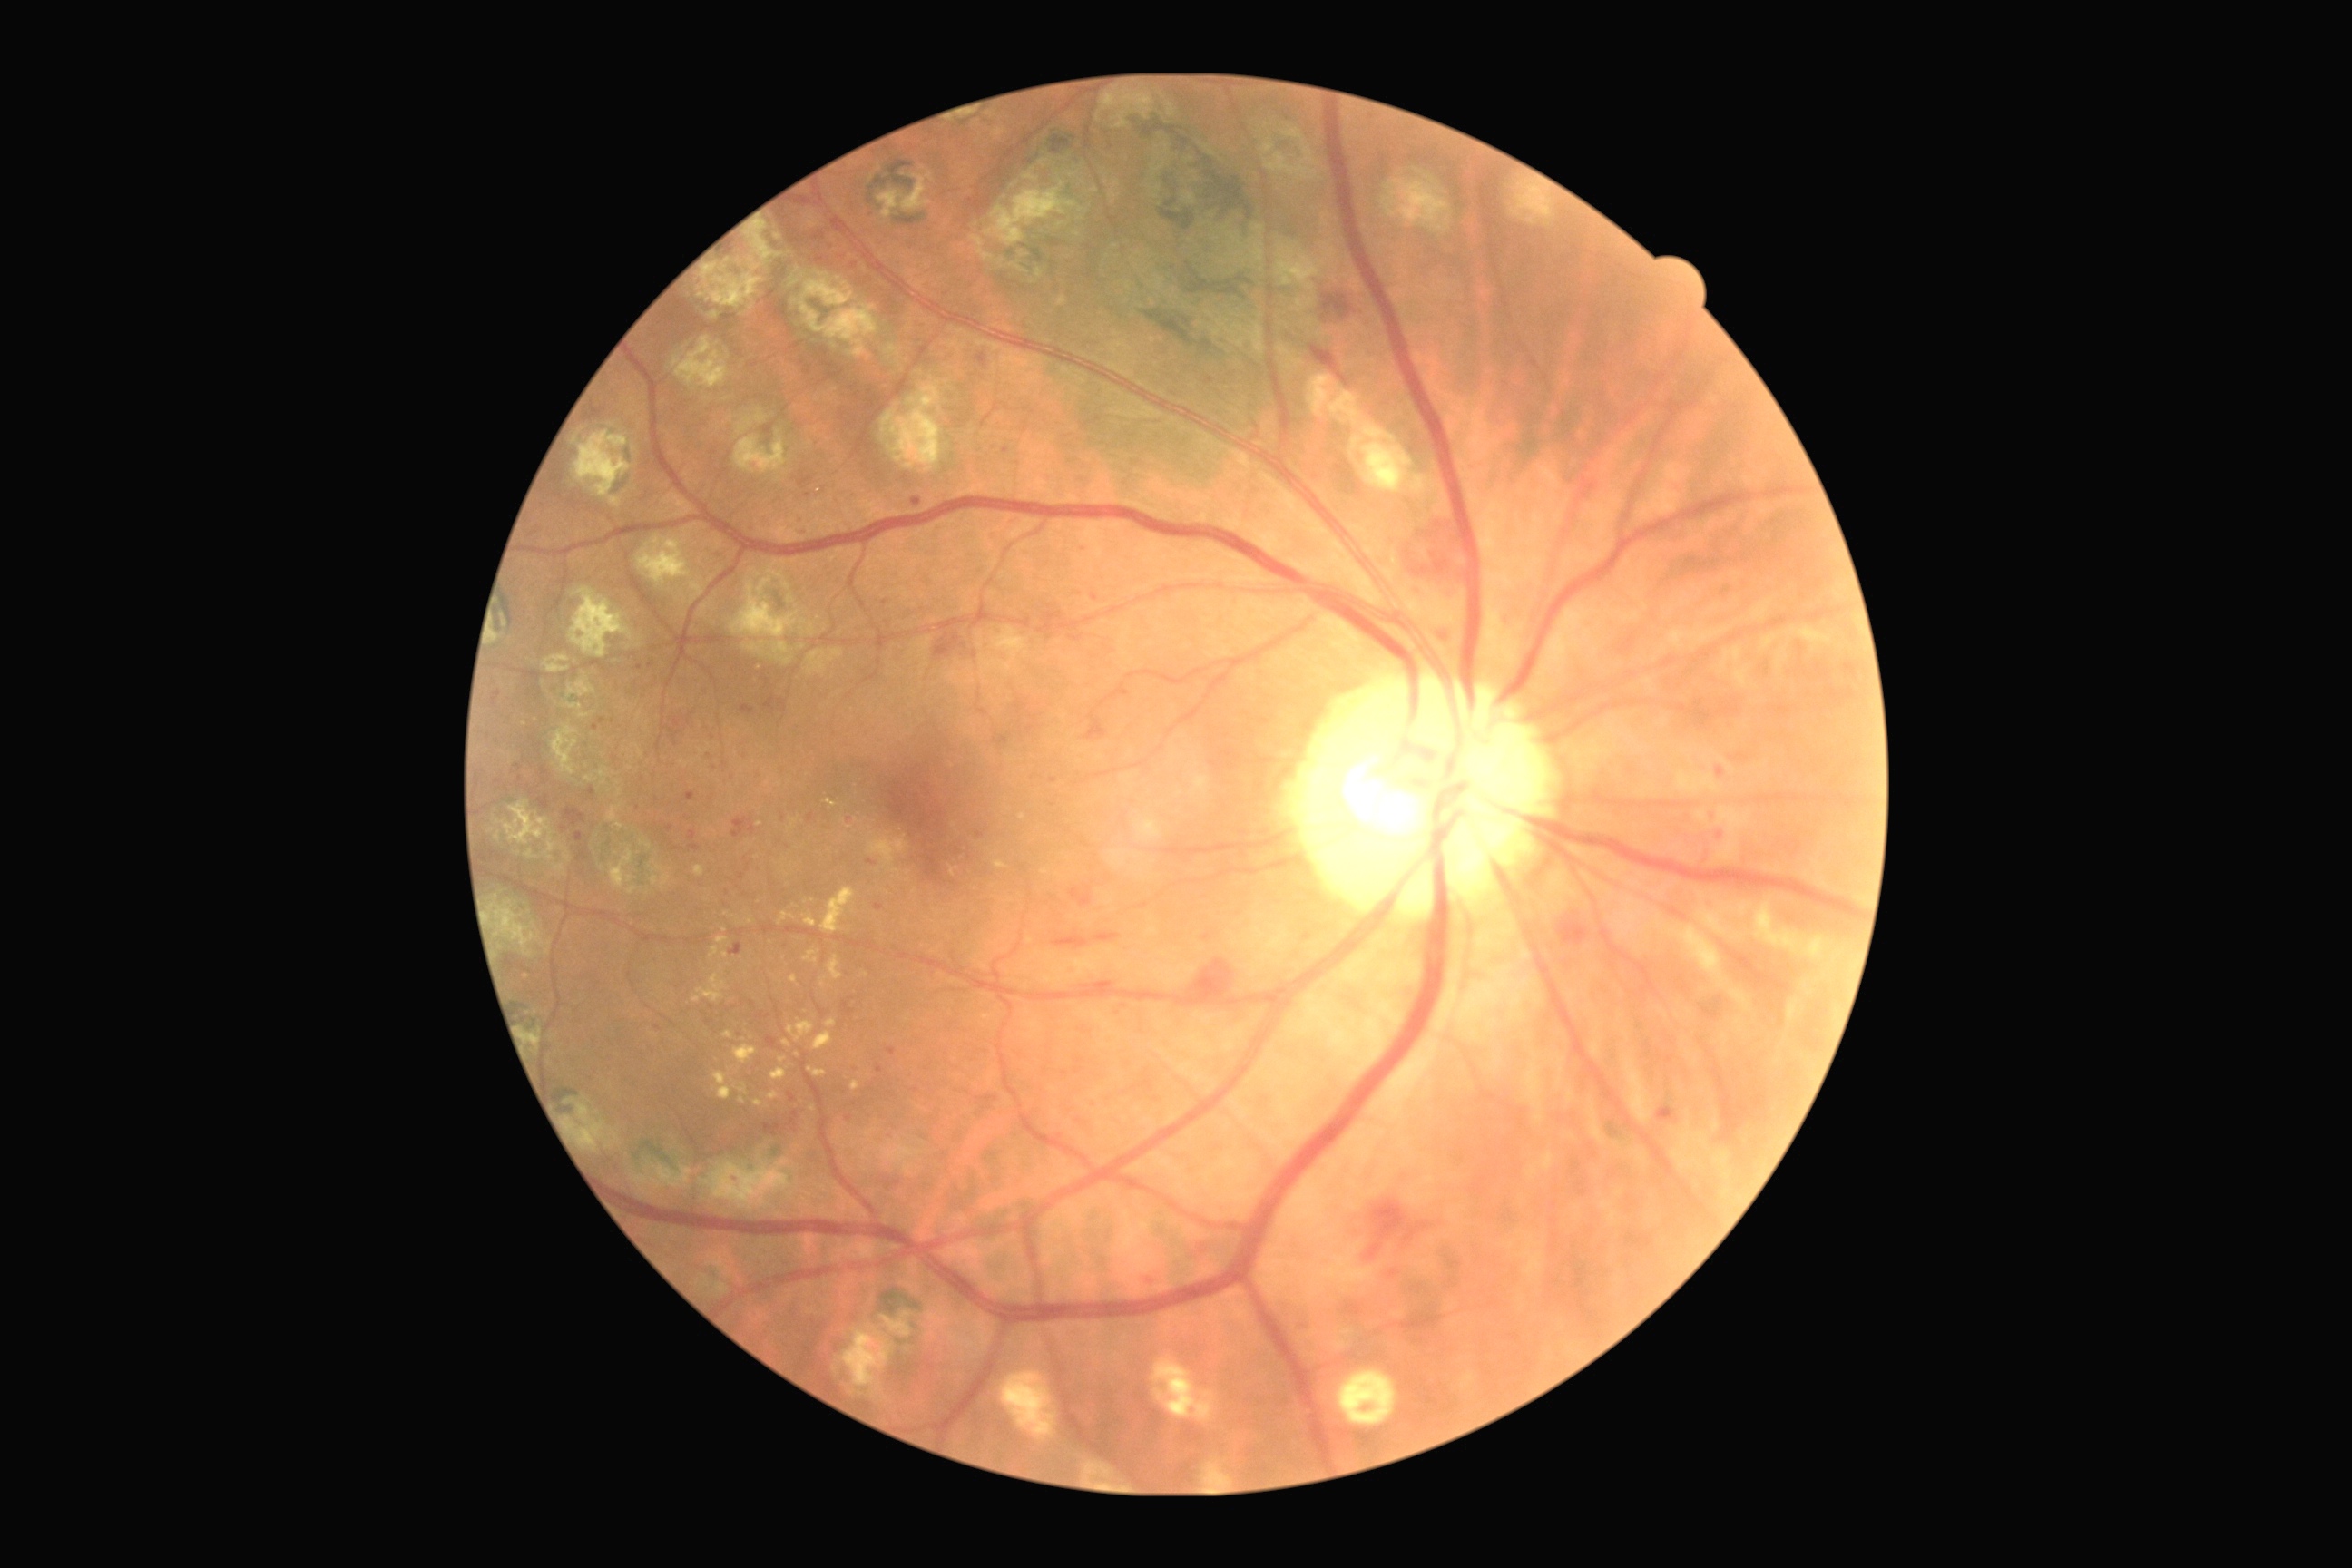
dr_grade: grade 2 (moderate NPDR)